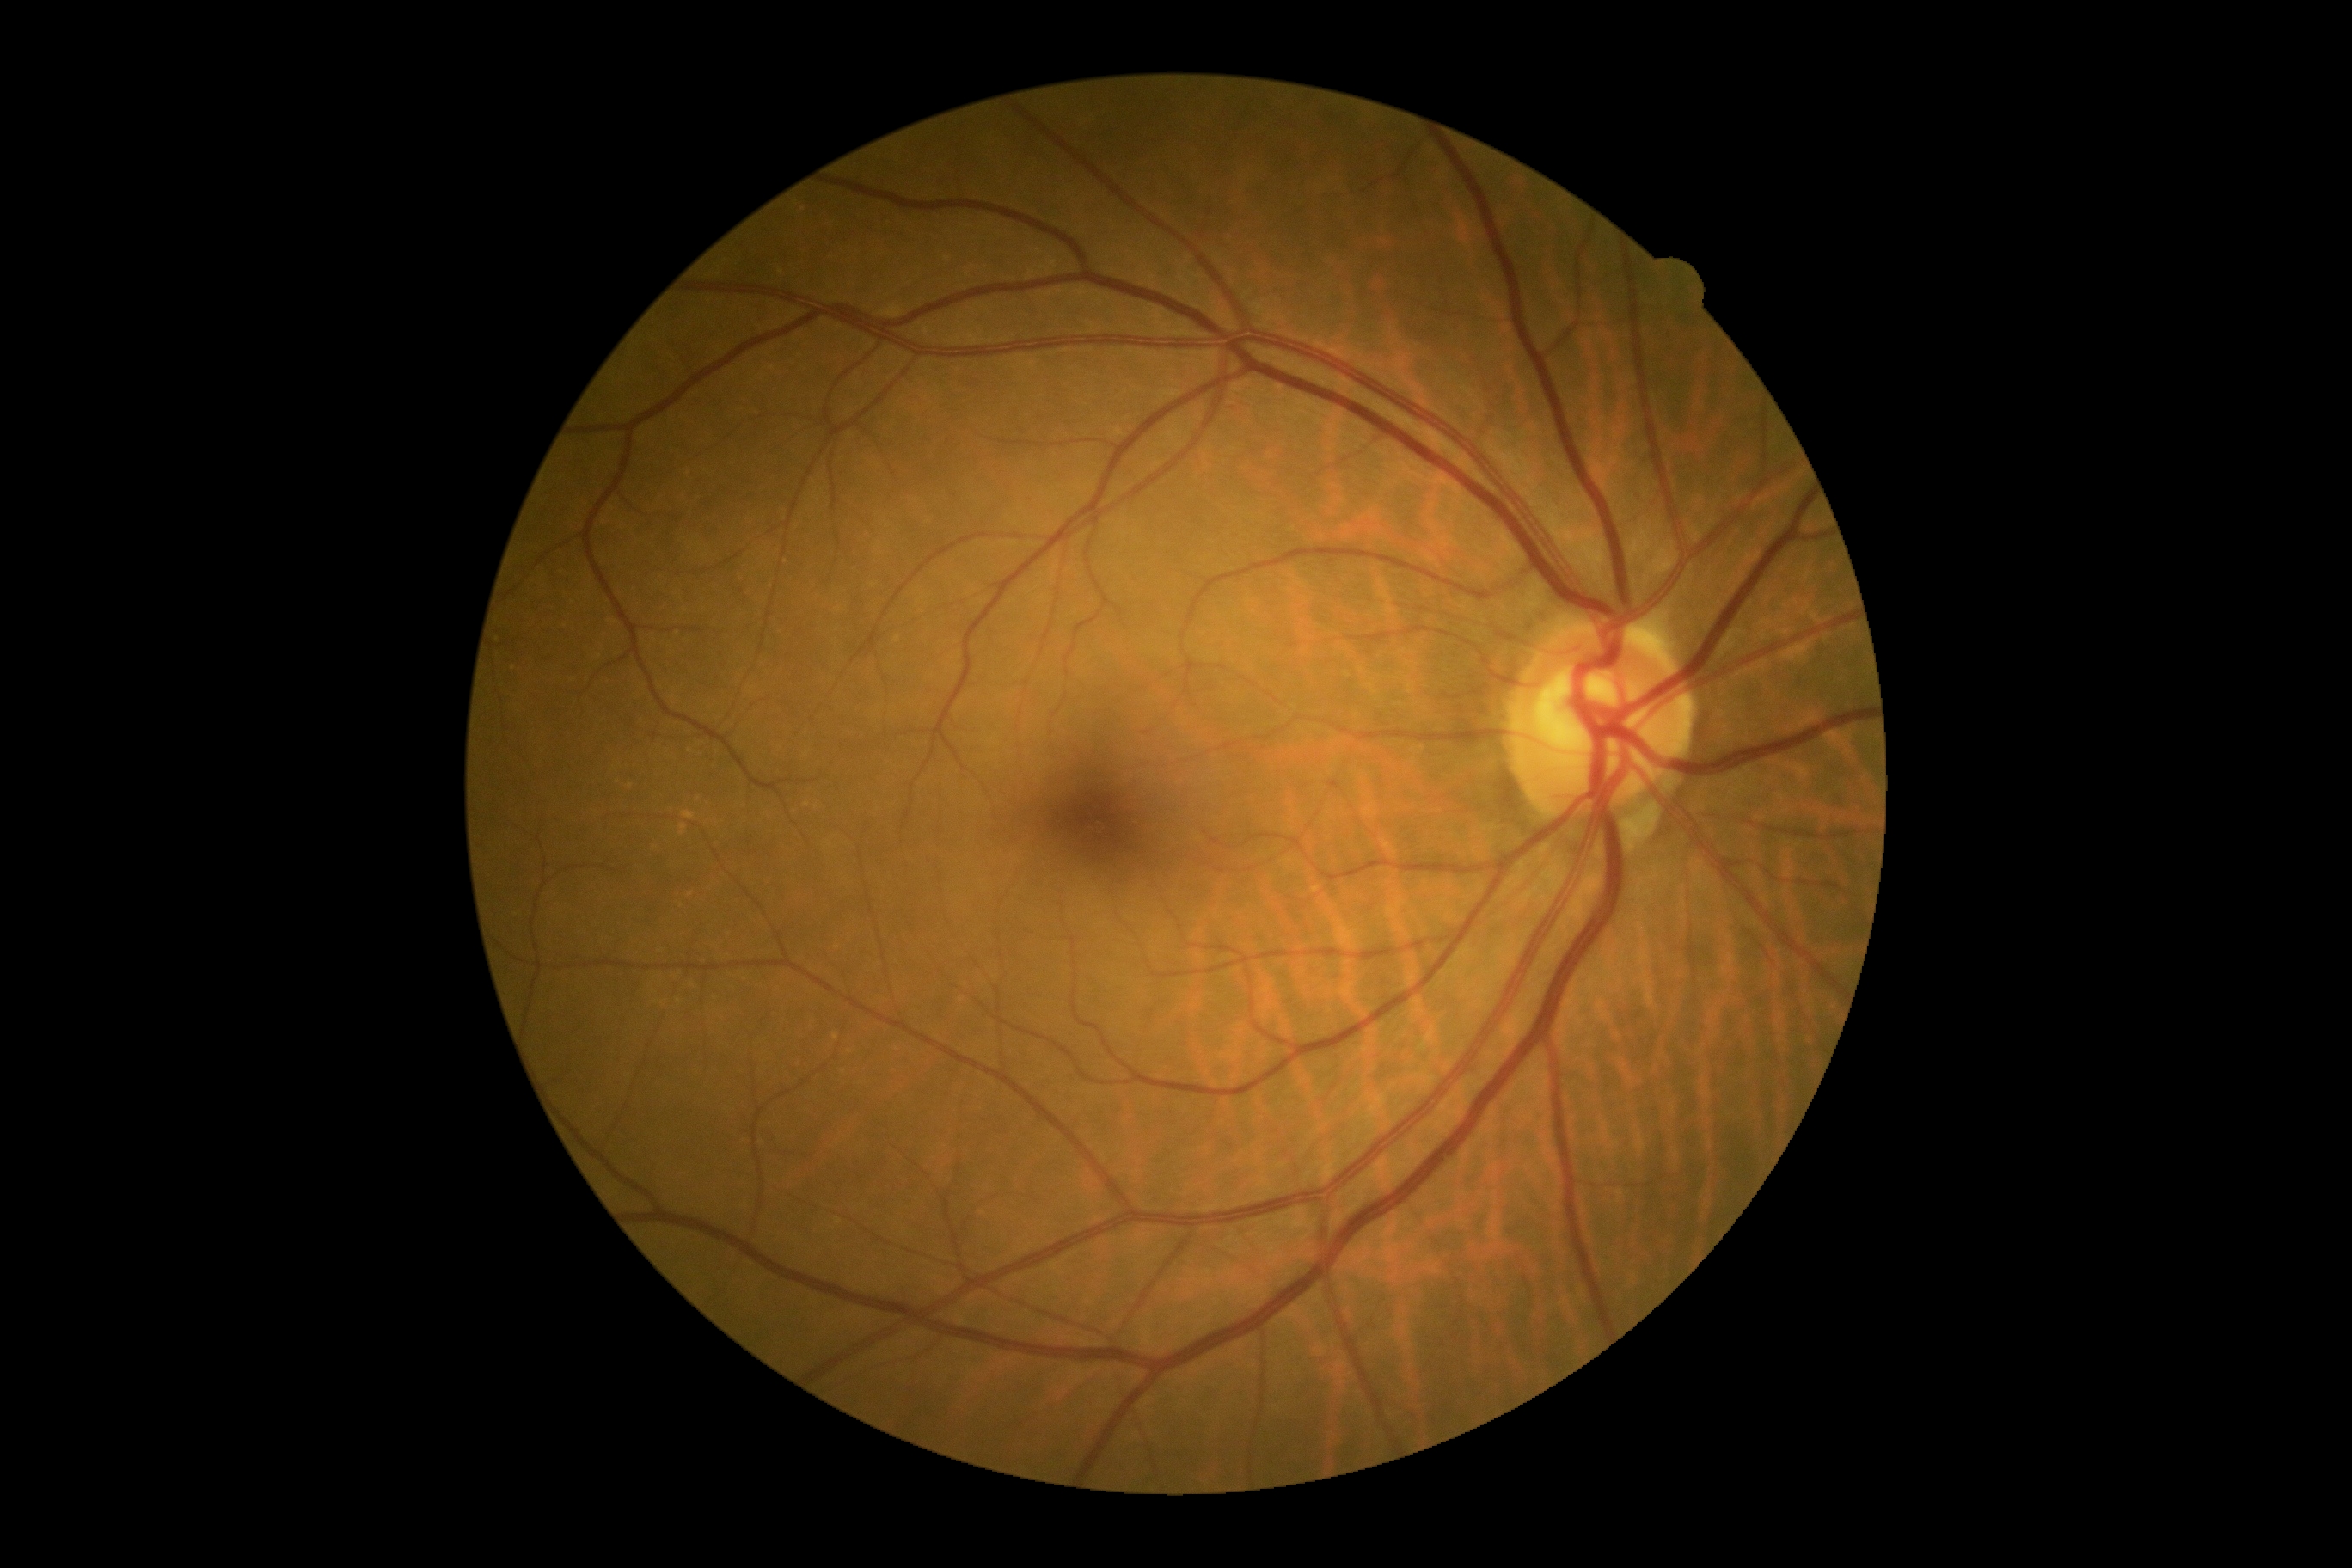

DR impression: negative for DR; diabetic retinopathy (DR): grade 0 (no apparent retinopathy).